Pediatric retinal photograph (wide-field).
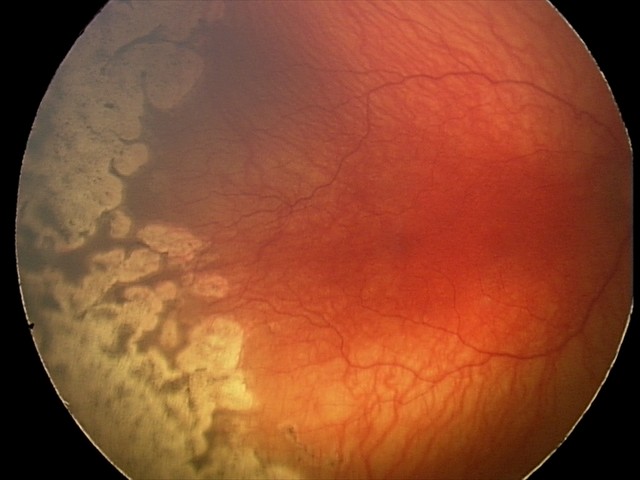
Plus form: present, diagnosis: A-ROP (aggressive ROP) — rapidly progressive severe ROP with prominent plus disease, often without classic stage progression.